FOV 35° before cropping; ONH-centered crop from a color fundus image; mydriatic acquisition — 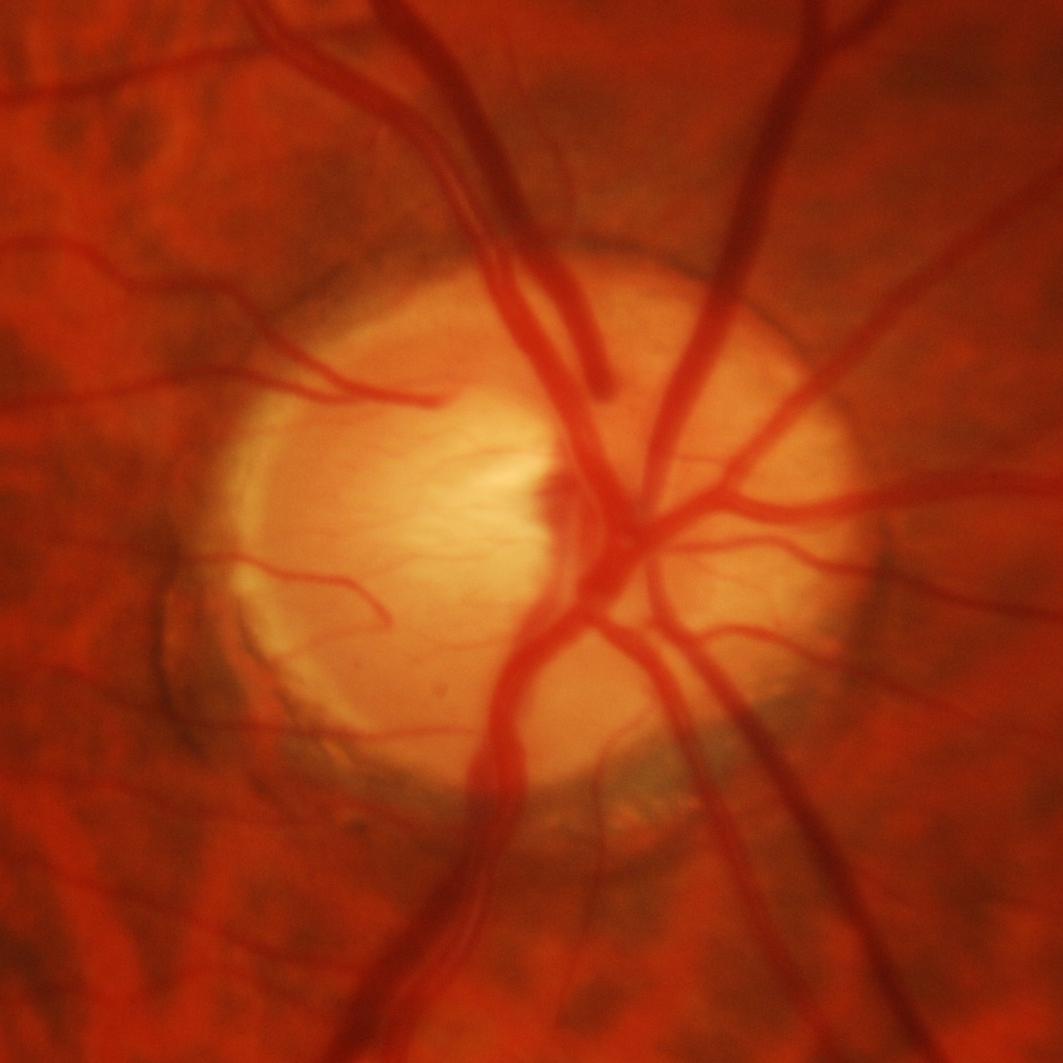 Glaucoma status = present.